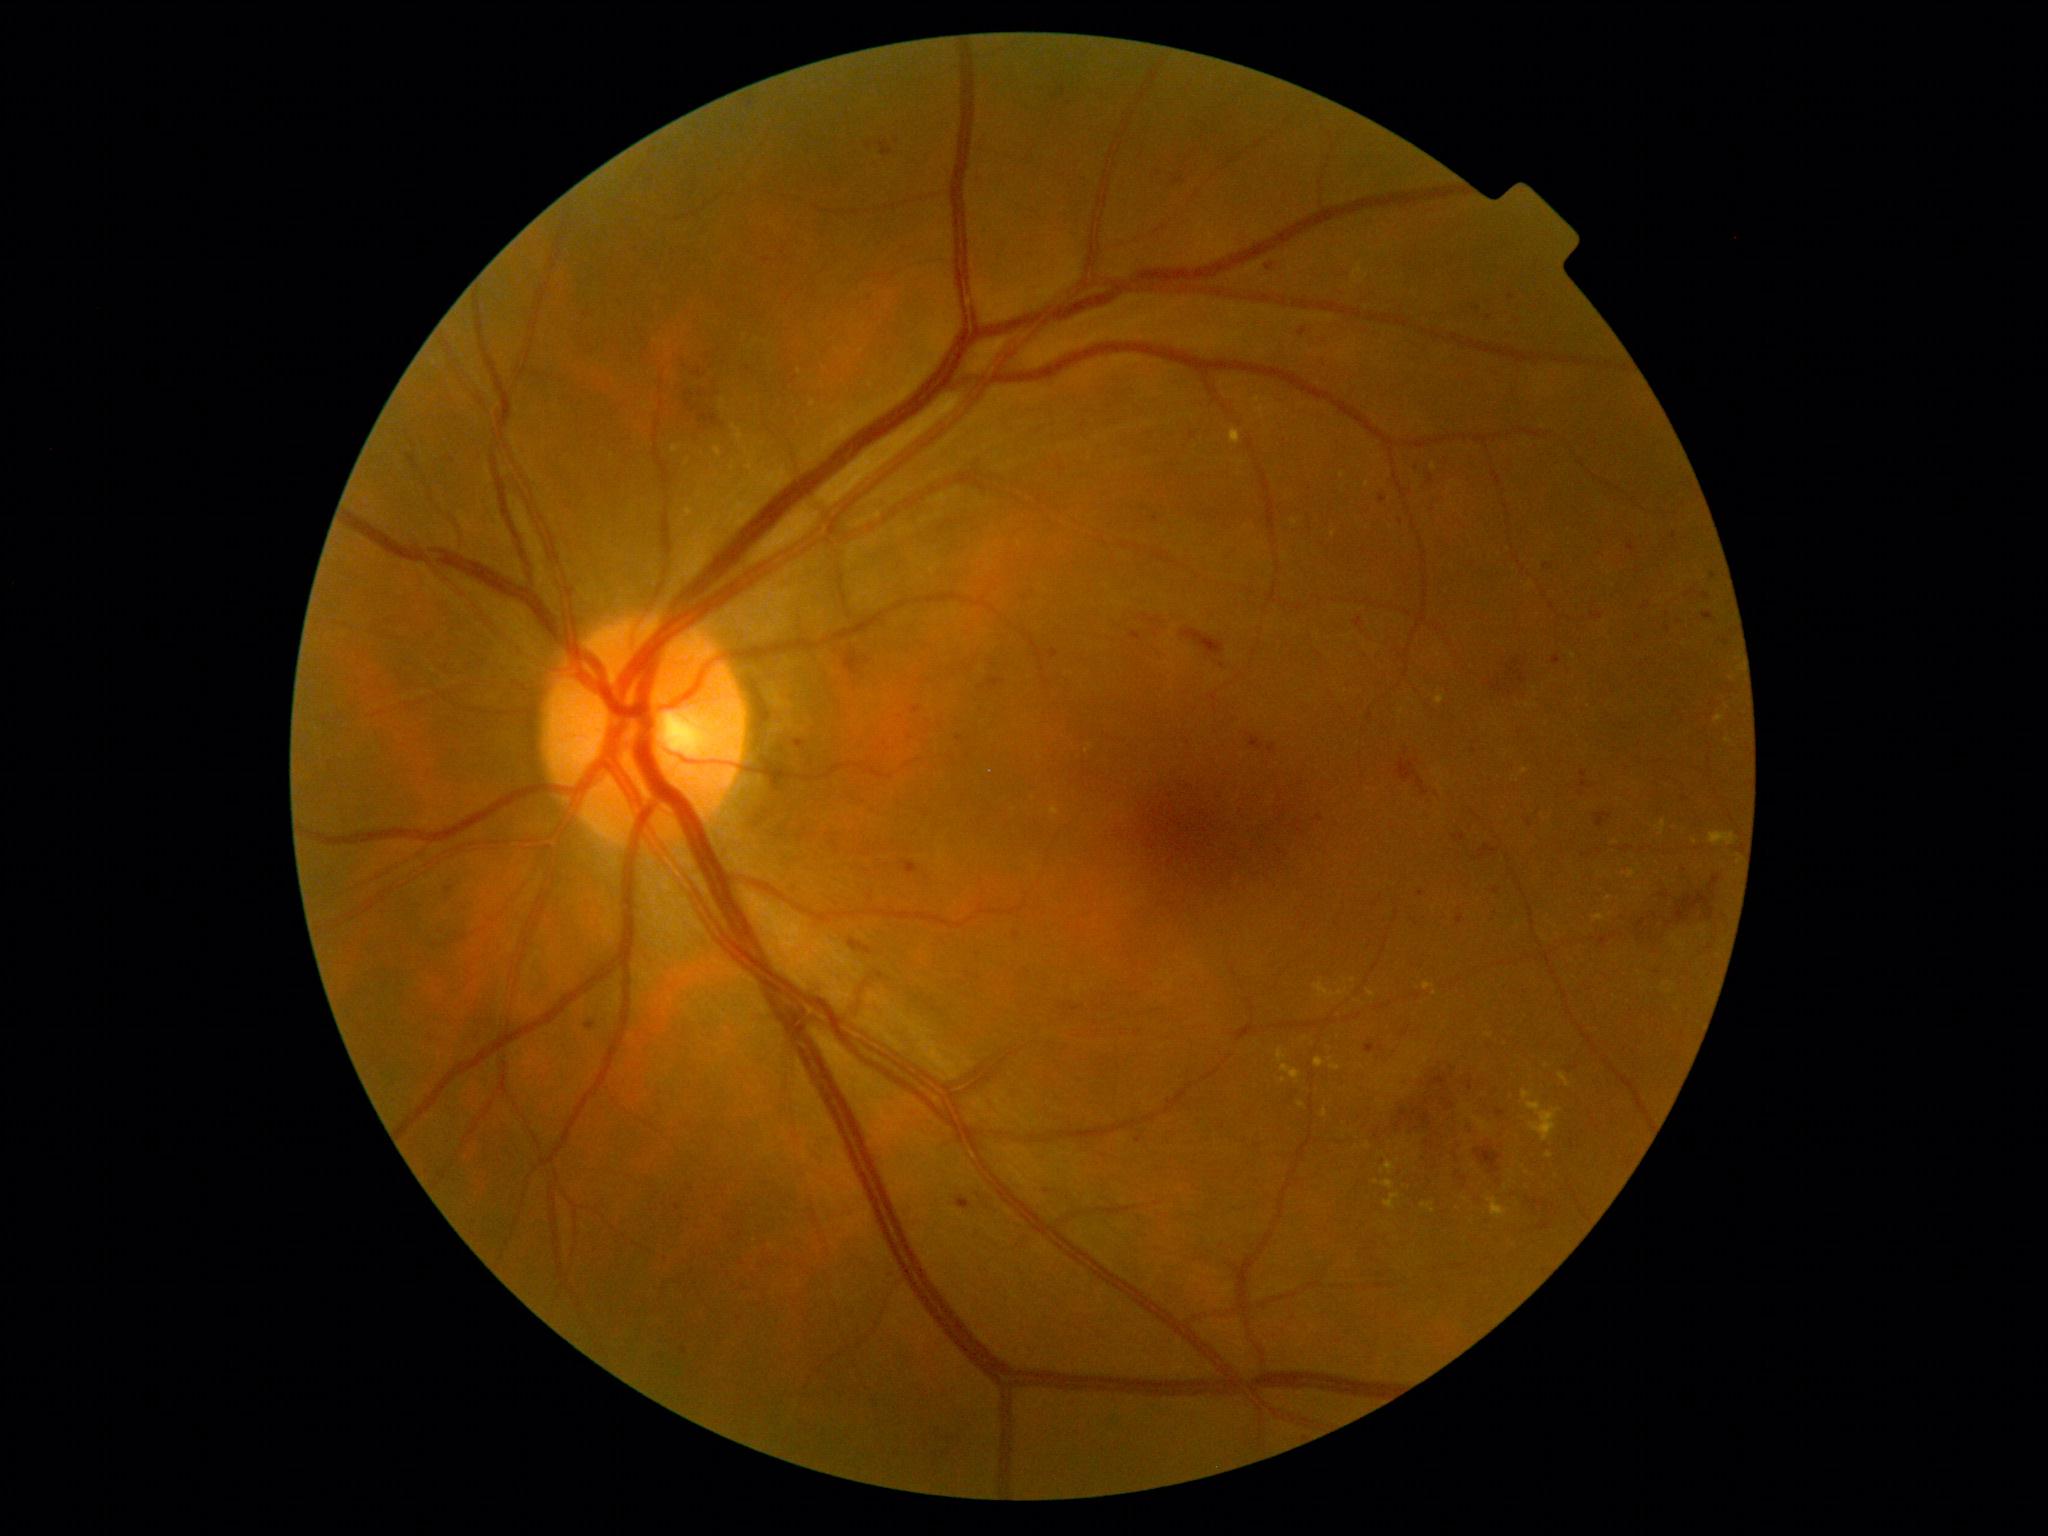 dr_grade: 3/4
dr_category: non-proliferative diabetic retinopathy